Wide-field fundus photograph of an infant; 640 x 480 pixels; camera: Clarity RetCam 3 (130° FOV).
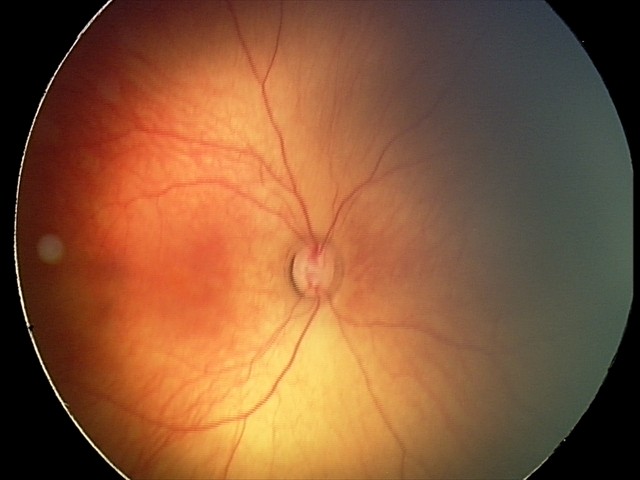
Q: What is the screening diagnosis?
A: normal retinal appearance